Wide-field retinal mosaic image; 1924 by 1556 pixels — 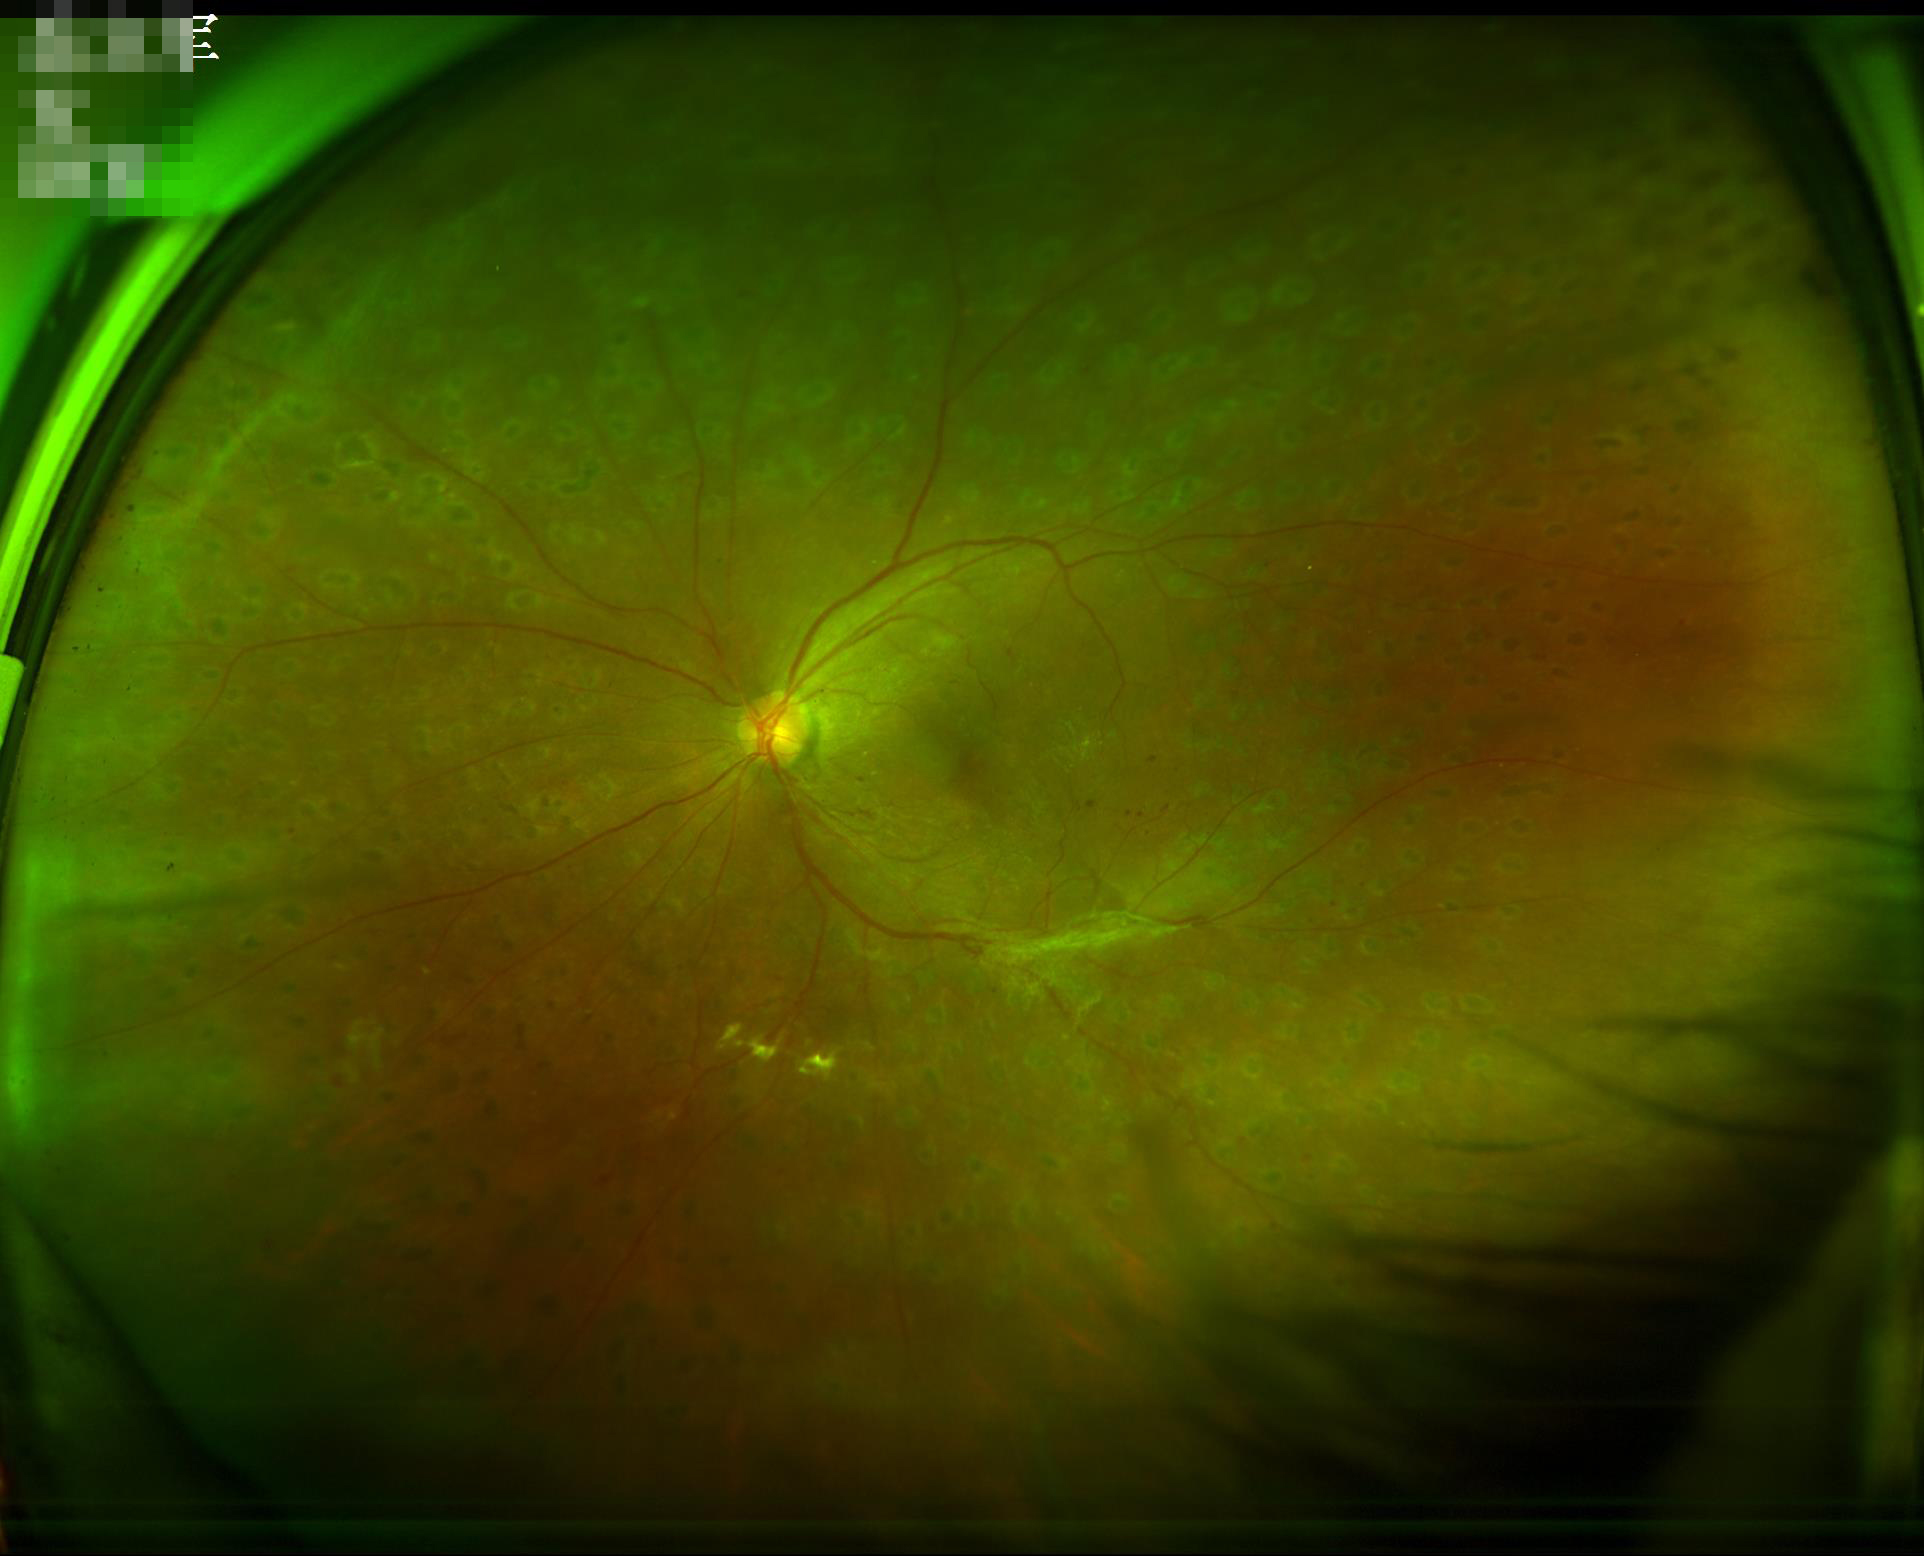 Good dynamic range. Overall image quality is good. No over- or under-exposure.